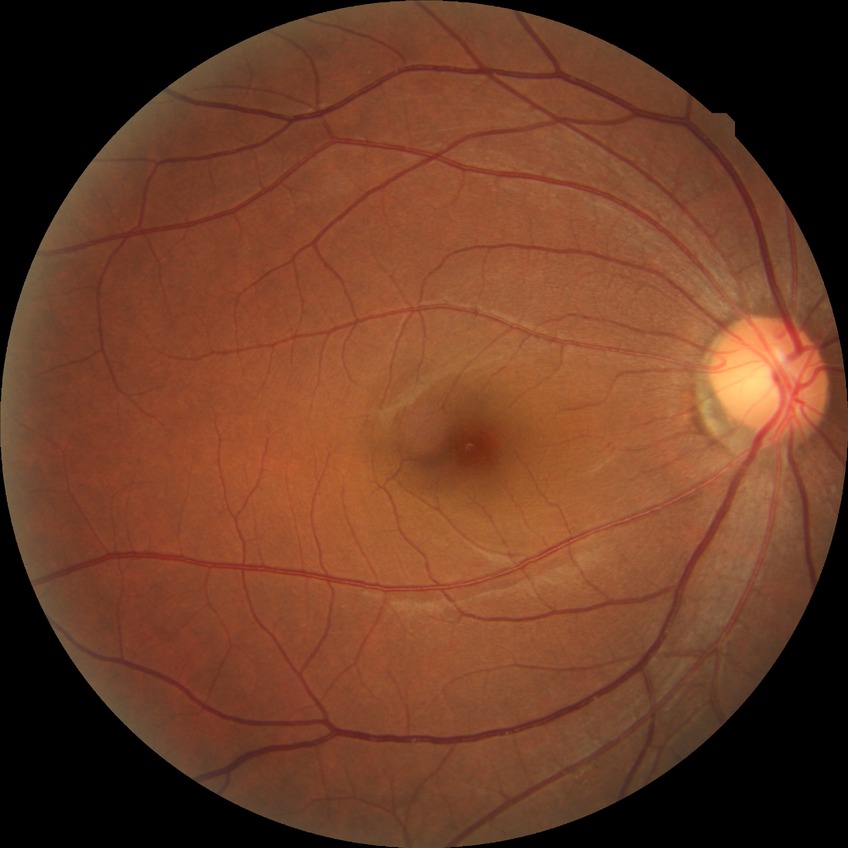
Diabetic retinopathy grade is no diabetic retinopathy.